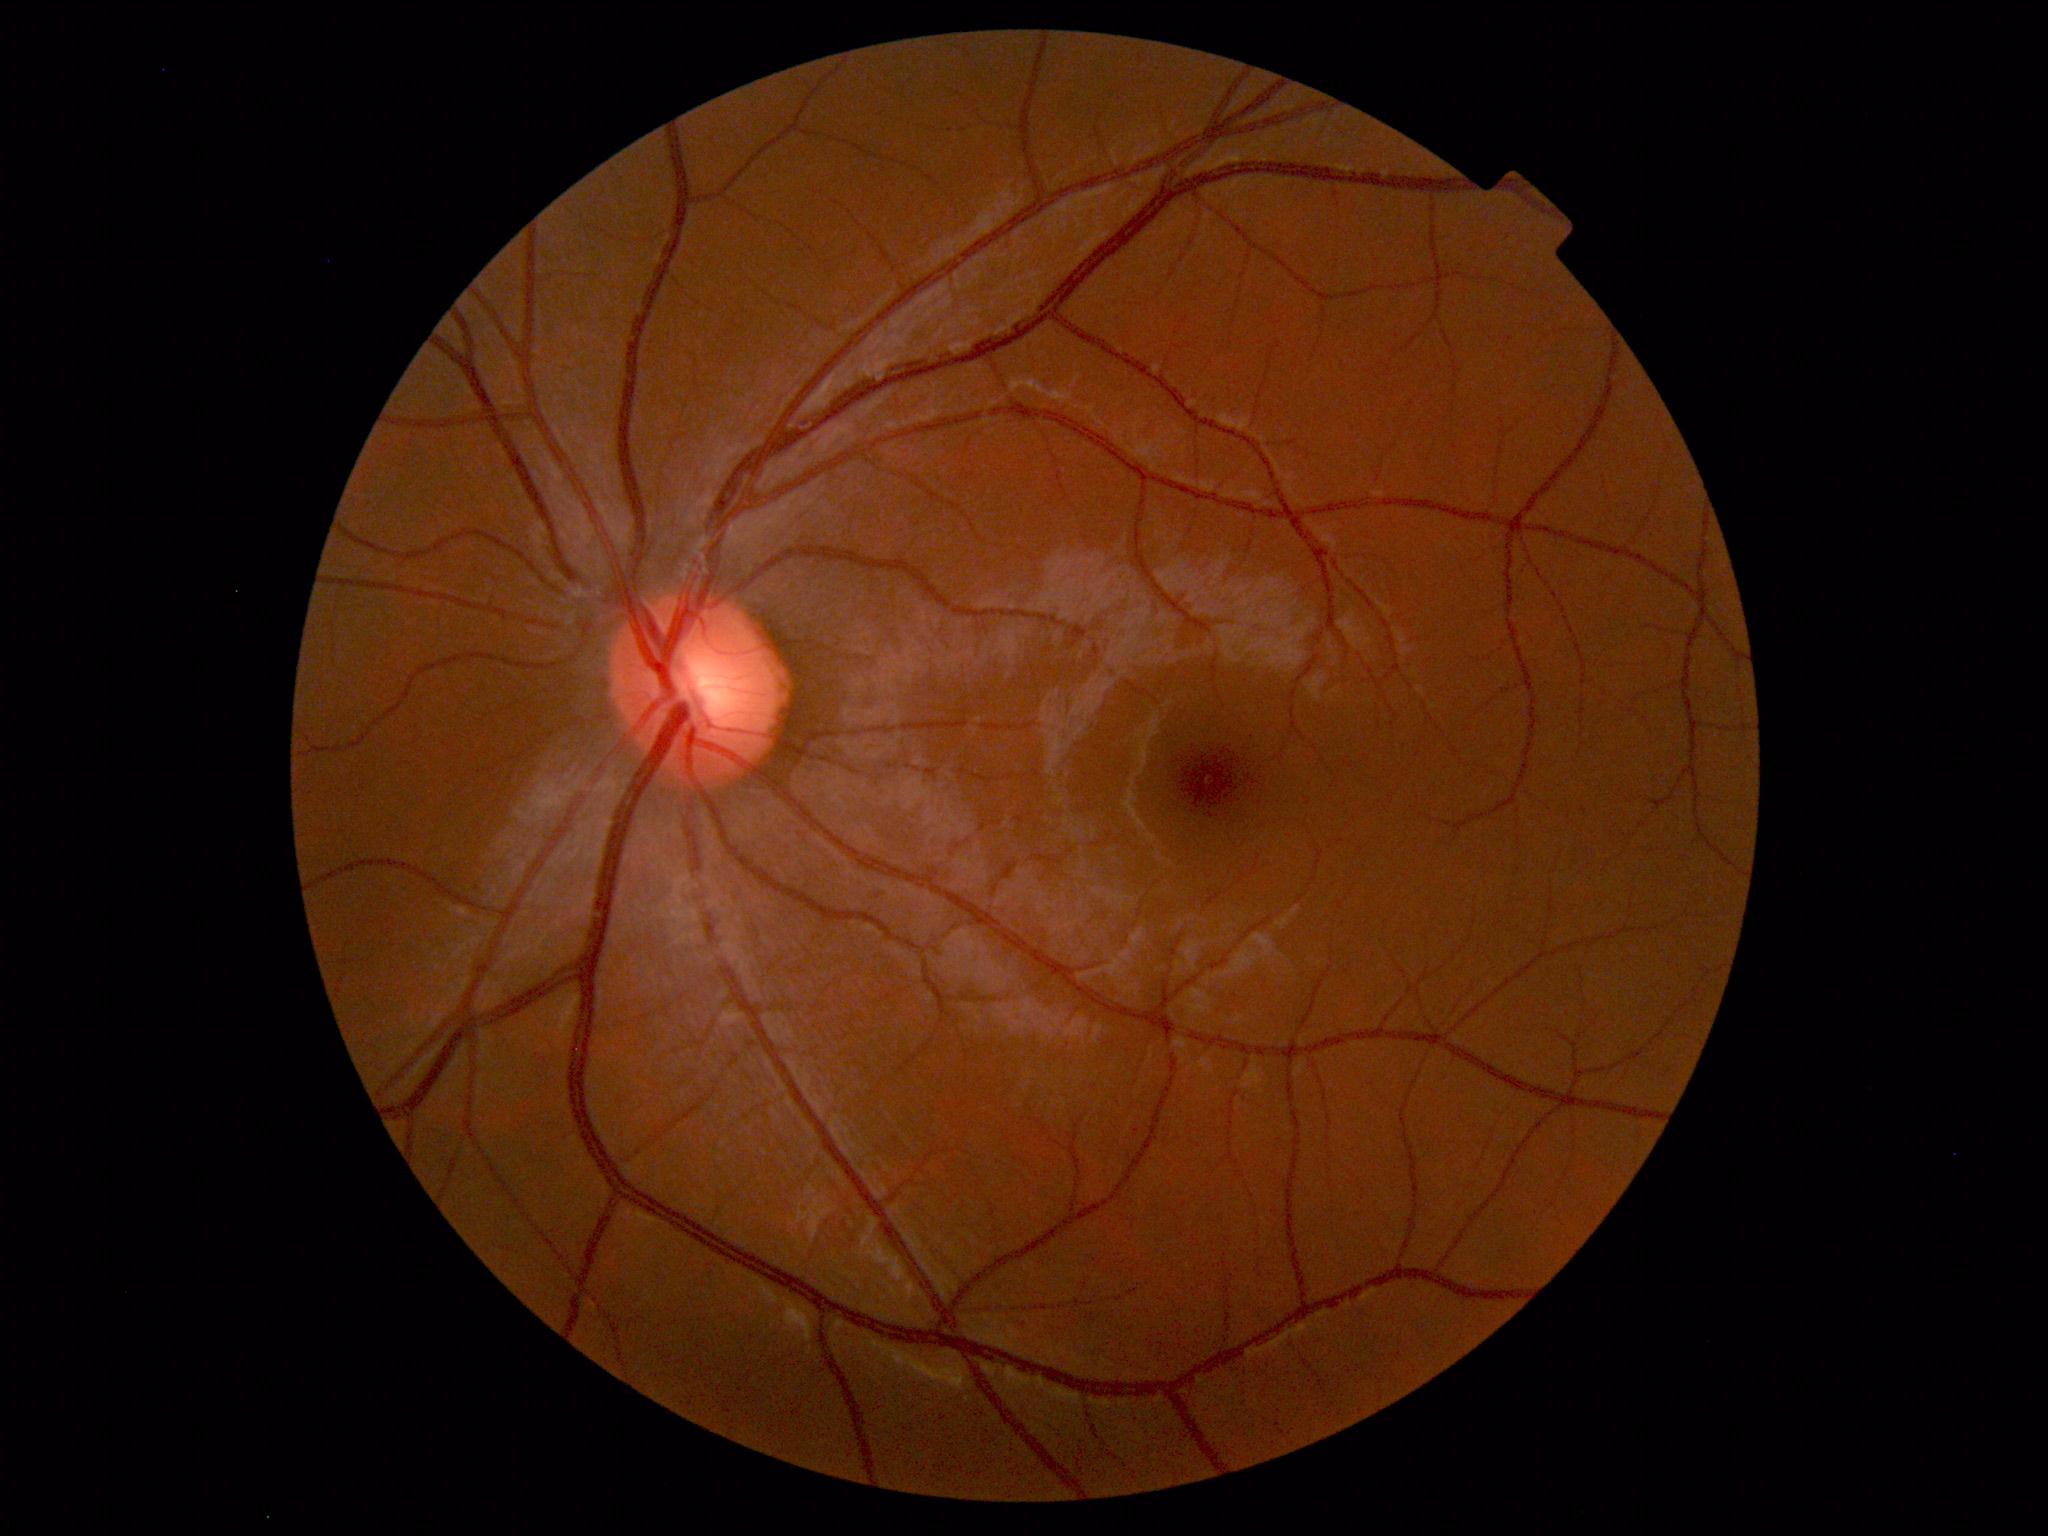 Impression: normal fundus.